Camera: NIDEK AFC-230 — 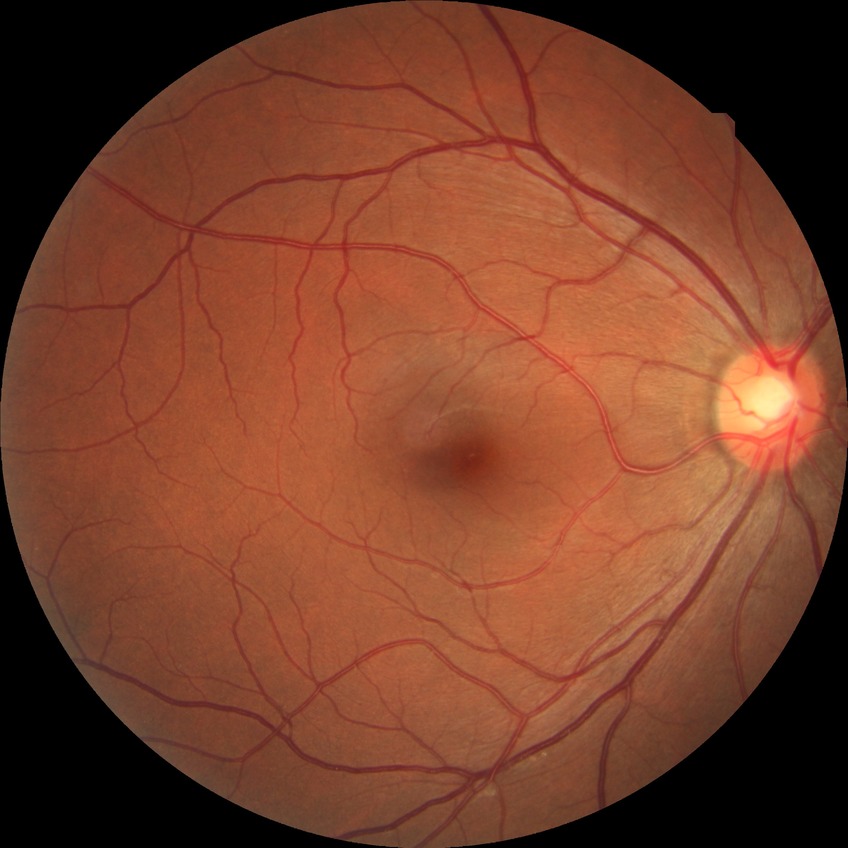 diabetic retinopathy (DR) = no diabetic retinopathy (NDR)